Color fundus image · image size 1932x1916.
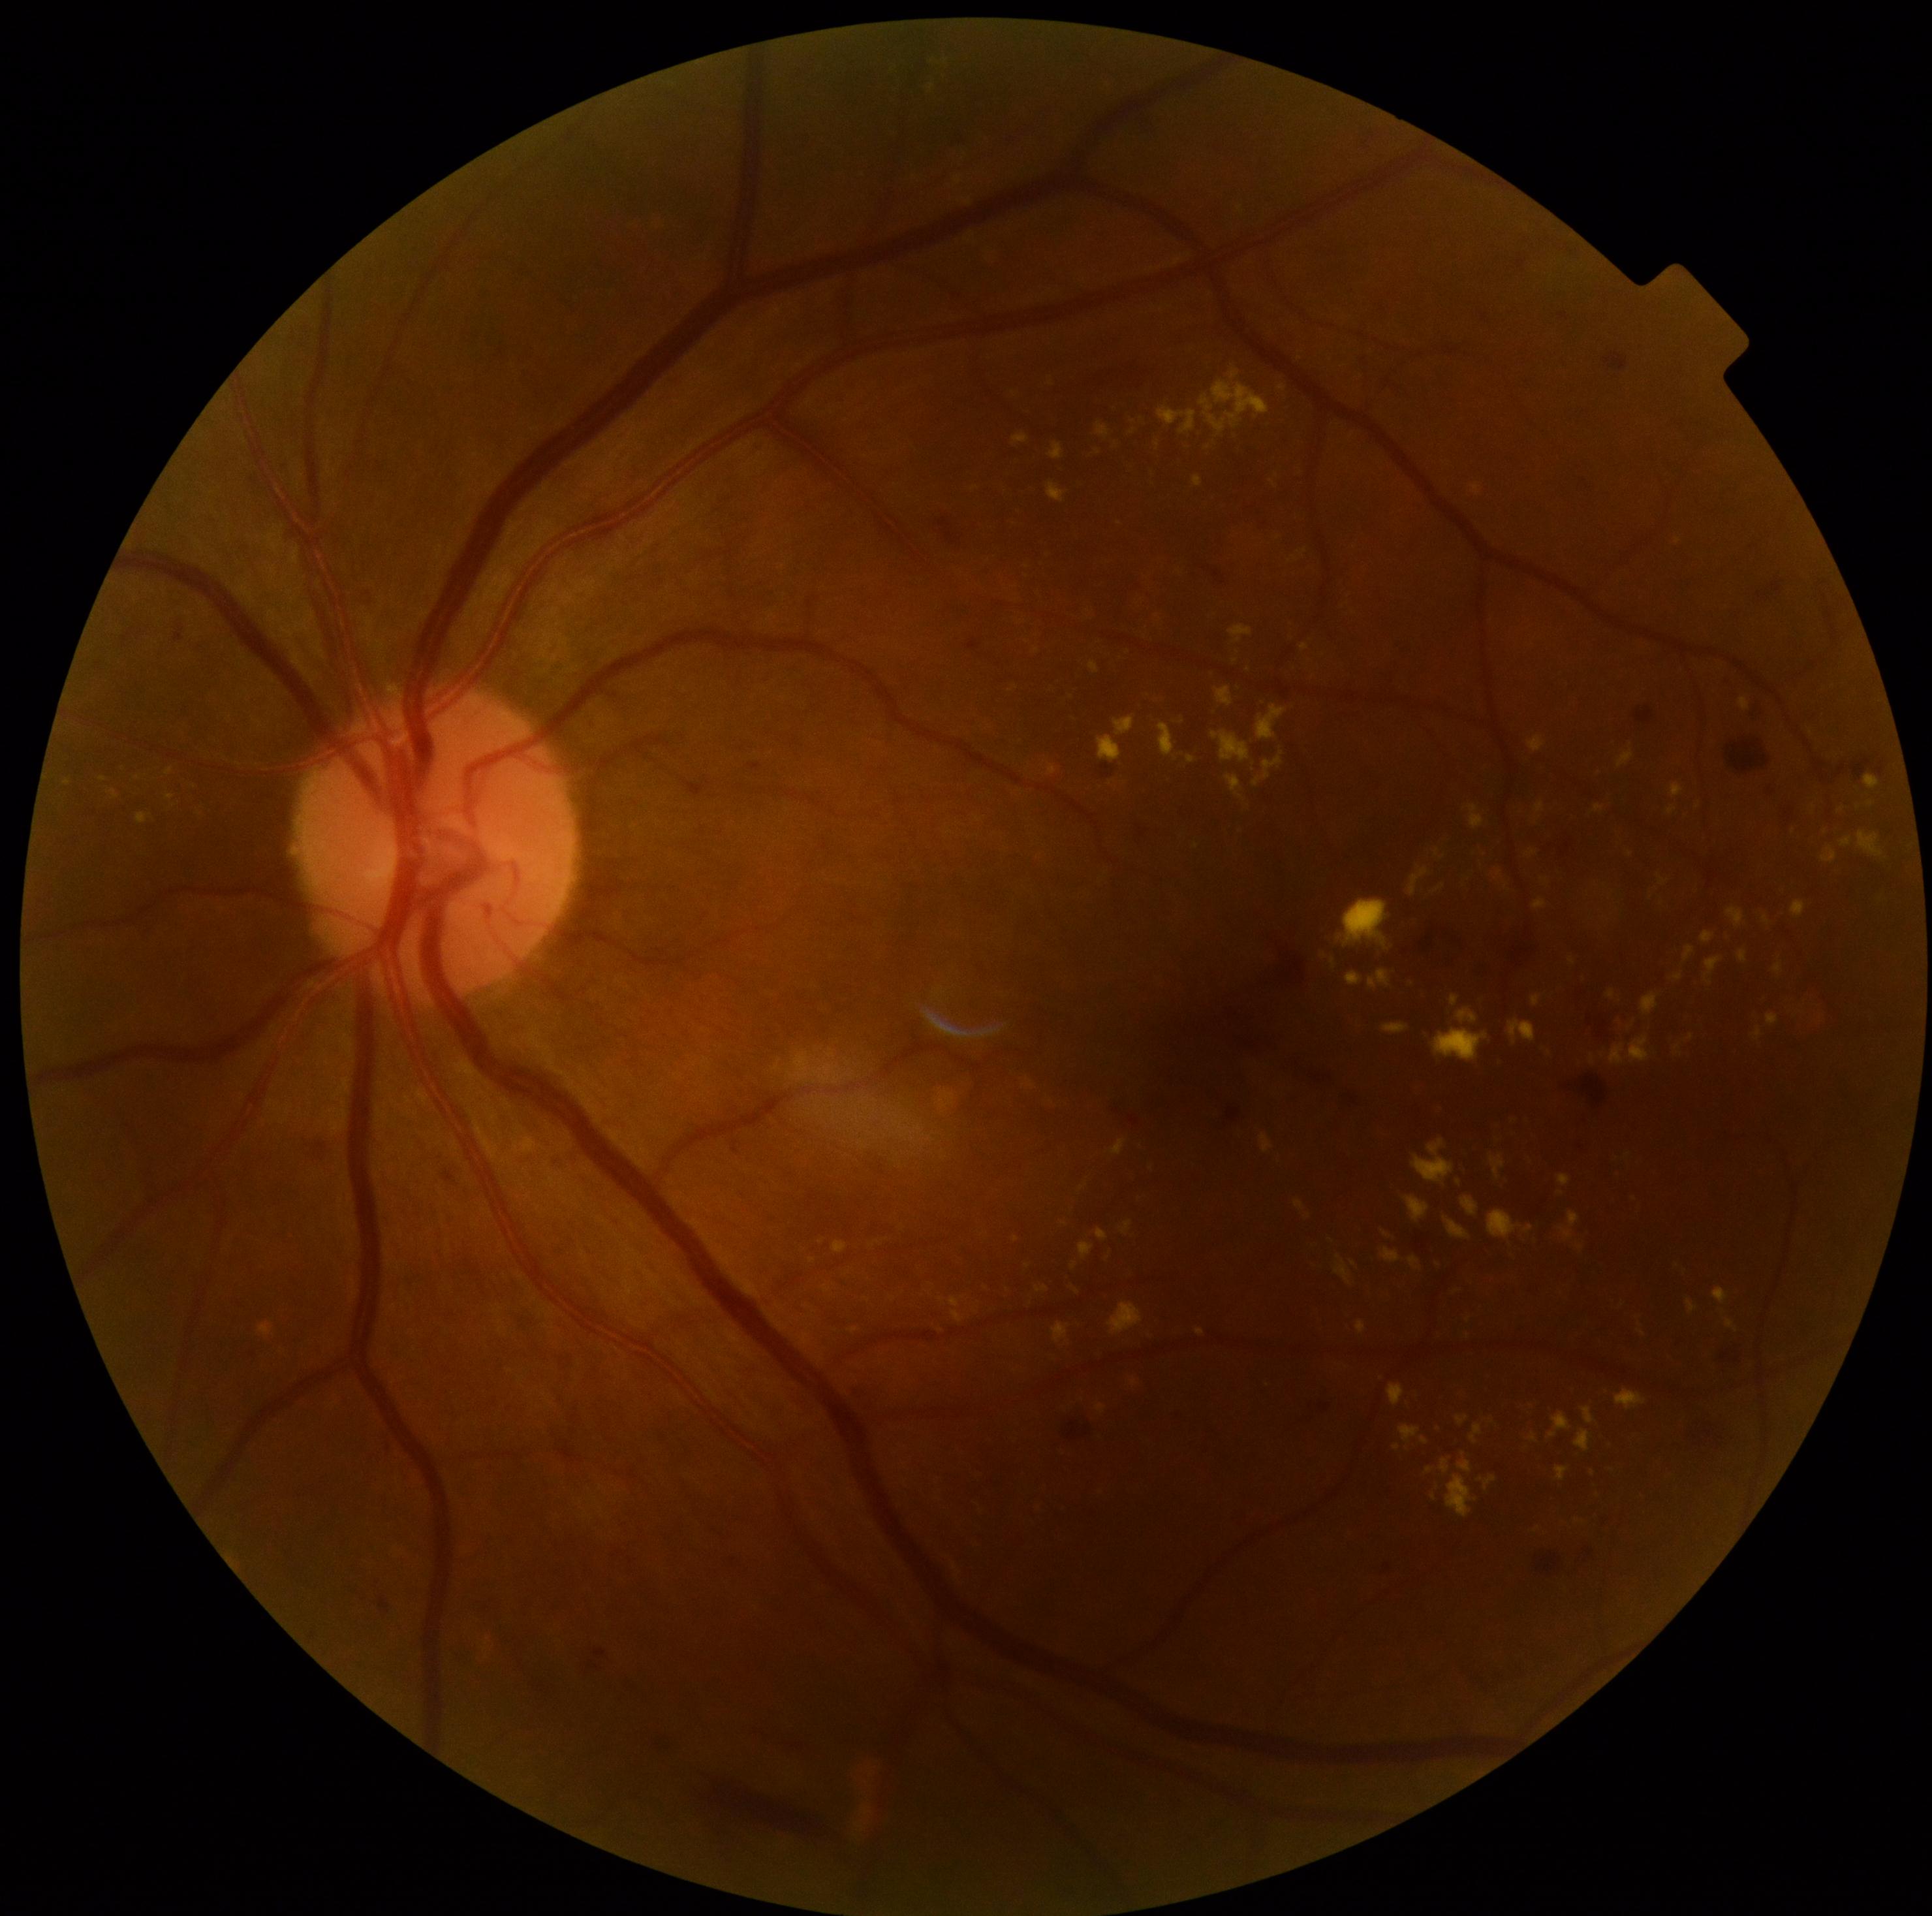
Diabetic retinopathy (DR) is moderate NPDR (grade 2). Hemorrhages (HEs) include lesions at x1=1585, y1=1548, x2=1595, y2=1556; x1=1568, y1=990, x2=1604, y2=1042; x1=580, y1=1645, x2=617, y2=1674; x1=1138, y1=825, x2=1148, y2=838; x1=304, y1=1133, x2=326, y2=1161; x1=1413, y1=922, x2=1472, y2=970; x1=1583, y1=1075, x2=1608, y2=1108; x1=698, y1=1772, x2=837, y2=1857; x1=1635, y1=706, x2=1655, y2=725; x1=1067, y1=1421, x2=1089, y2=1440; x1=1826, y1=747, x2=1883, y2=786; x1=1726, y1=739, x2=1772, y2=773. No soft exudates (SEs) identified. Microaneurysms (MAs) present at x1=750, y1=764, x2=760, y2=772; x1=1729, y1=678, x2=1739, y2=689; x1=968, y1=638, x2=981, y2=650; x1=1320, y1=1404, x2=1330, y2=1413; x1=443, y1=1170, x2=455, y2=1182; x1=176, y1=628, x2=185, y2=642; x1=381, y1=1595, x2=390, y2=1610; x1=1785, y1=808, x2=1794, y2=820; x1=1204, y1=567, x2=1226, y2=585; x1=1226, y1=1107, x2=1242, y2=1122; x1=1516, y1=257, x2=1525, y2=268; x1=733, y1=1140, x2=738, y2=1154; x1=1559, y1=313, x2=1570, y2=320; x1=720, y1=1562, x2=730, y2=1567. Small MAs near [1484, 317]; [1388, 1566]; [1580, 1147]. Hard exudates (EXs) include lesions at x1=1550, y1=1413, x2=1572, y2=1439; x1=1012, y1=433, x2=1029, y2=447; x1=1459, y1=1453, x2=1473, y2=1473; x1=1199, y1=368, x2=1270, y2=437; x1=1608, y1=990, x2=1615, y2=999; x1=1028, y1=1081, x2=1035, y2=1089; x1=1369, y1=971, x2=1391, y2=990; x1=1491, y1=870, x2=1508, y2=890; x1=1753, y1=1026, x2=1762, y2=1042; x1=772, y1=1316, x2=785, y2=1329; x1=1256, y1=704, x2=1286, y2=740; x1=1456, y1=1417, x2=1469, y2=1426; x1=1726, y1=1320, x2=1736, y2=1330. Small EXs near [1631, 1027]; [1196, 846]; [940, 1330]; [1698, 806]; [1692, 1036]; [1593, 1472].